Infant wide-field retinal image. Captured with the Clarity RetCam 3 (130° field of view) — 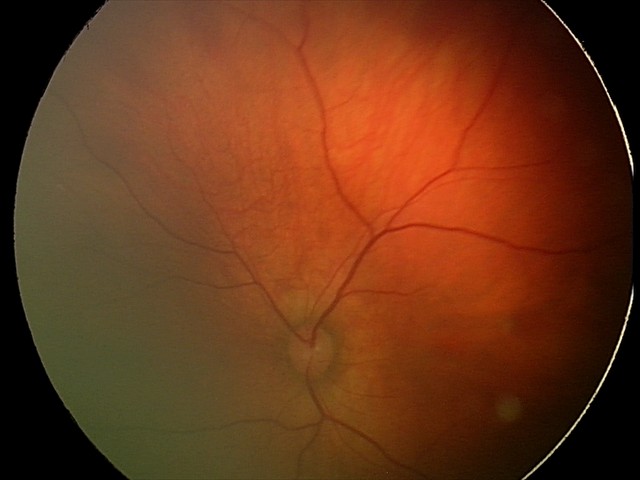

Impression: retinal hemorrhages.